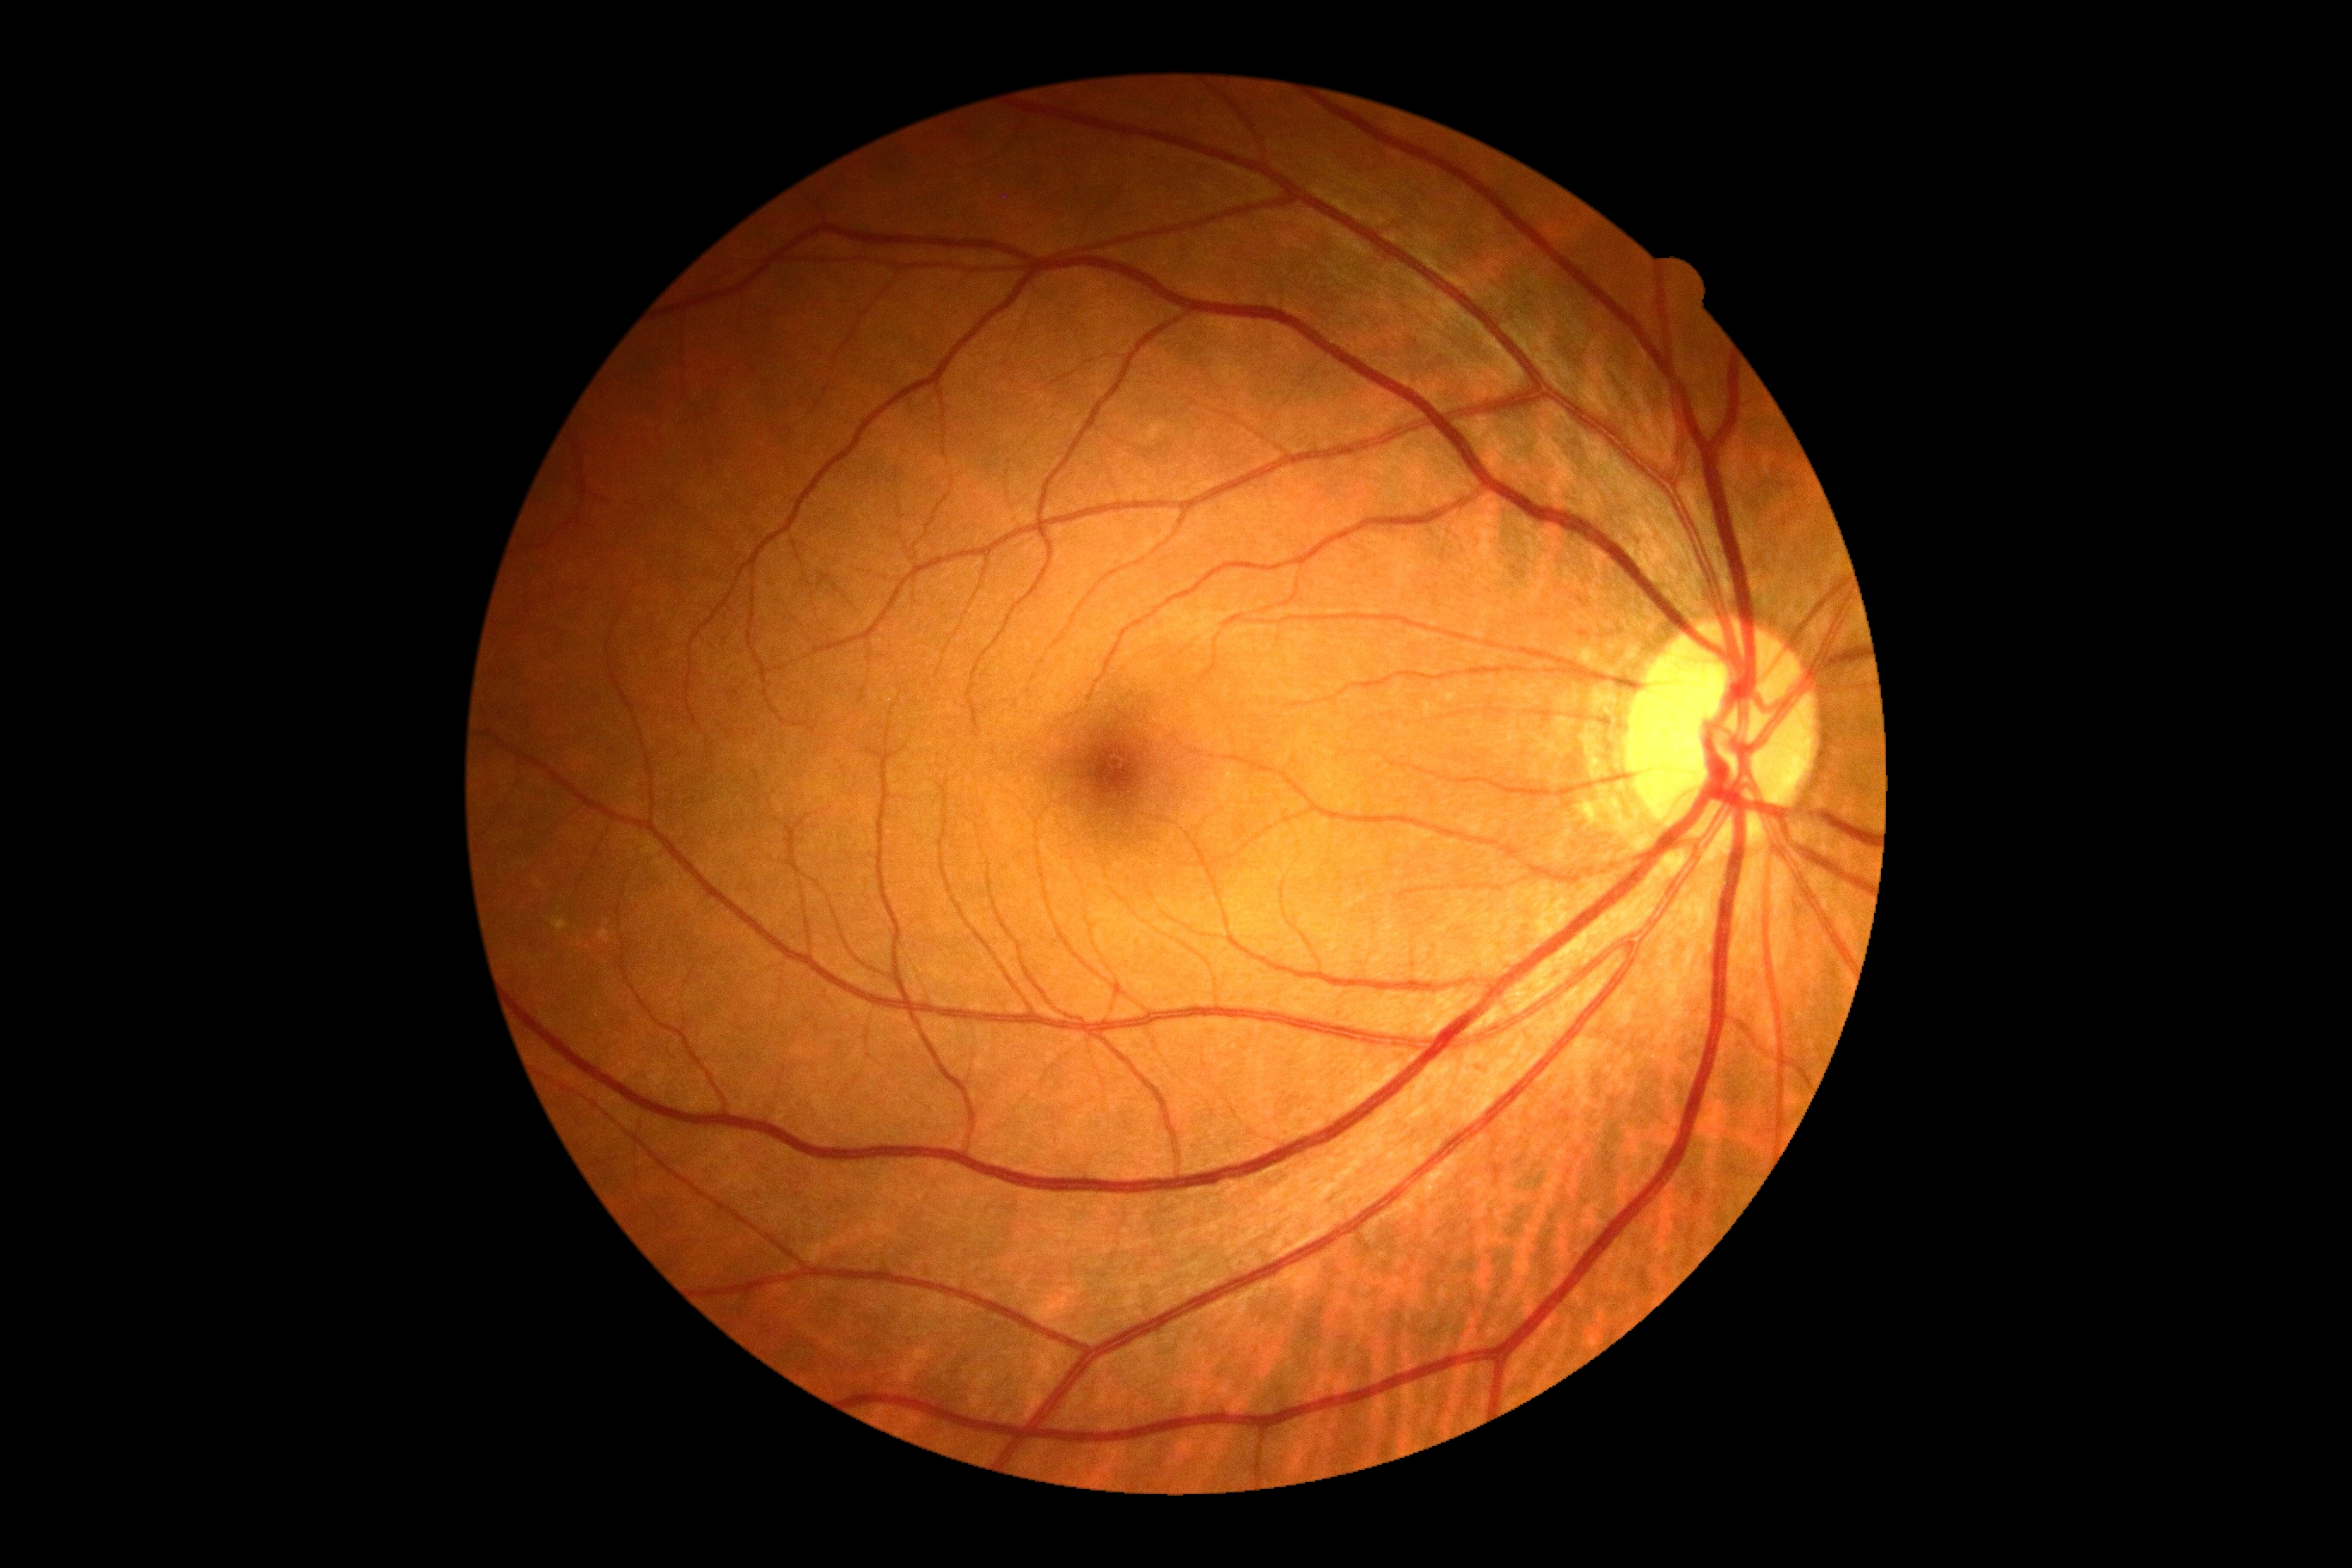

retinopathy: grade 0 | DR impression: negative for DR.